Acquired on the Clarity RetCam 3; wide-field fundus image from infant ROP screening — 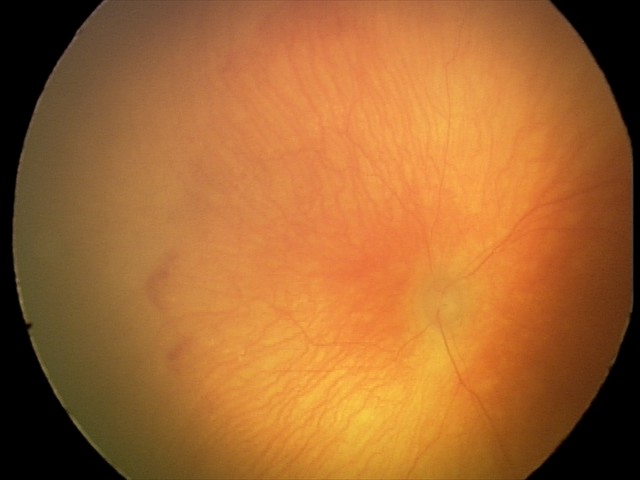
From an examination with diagnosis of A-ROP (aggressive ROP).
With plus disease.